848 x 848 pixels · DR severity per modified Davis staging:
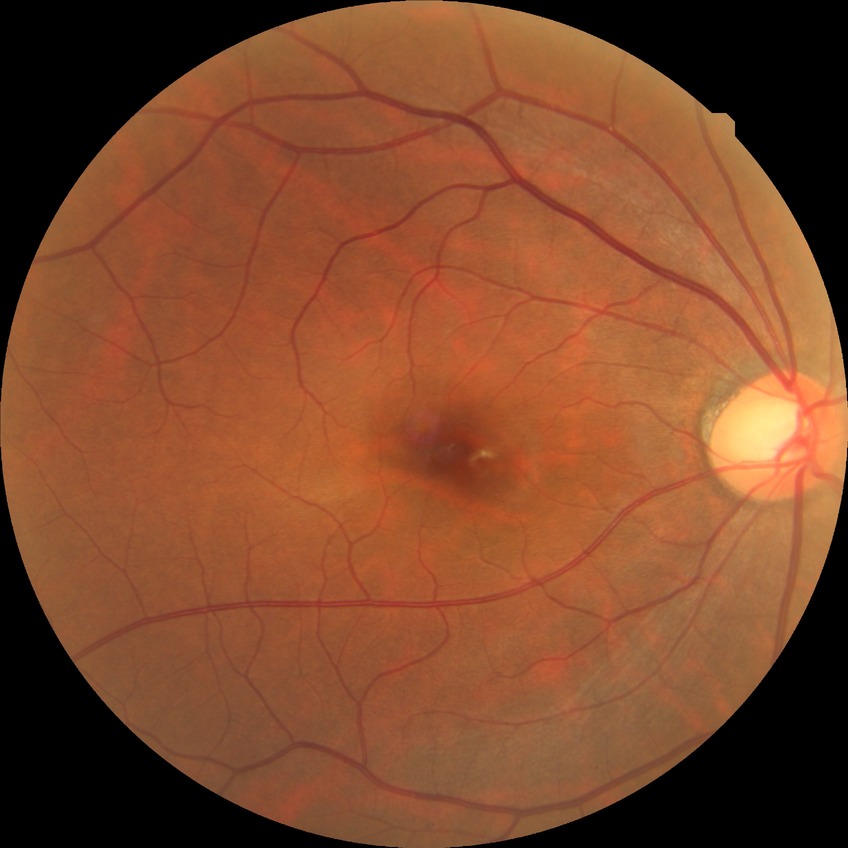 Diabetic retinopathy (DR): no diabetic retinopathy (NDR).